45-degree field of view:
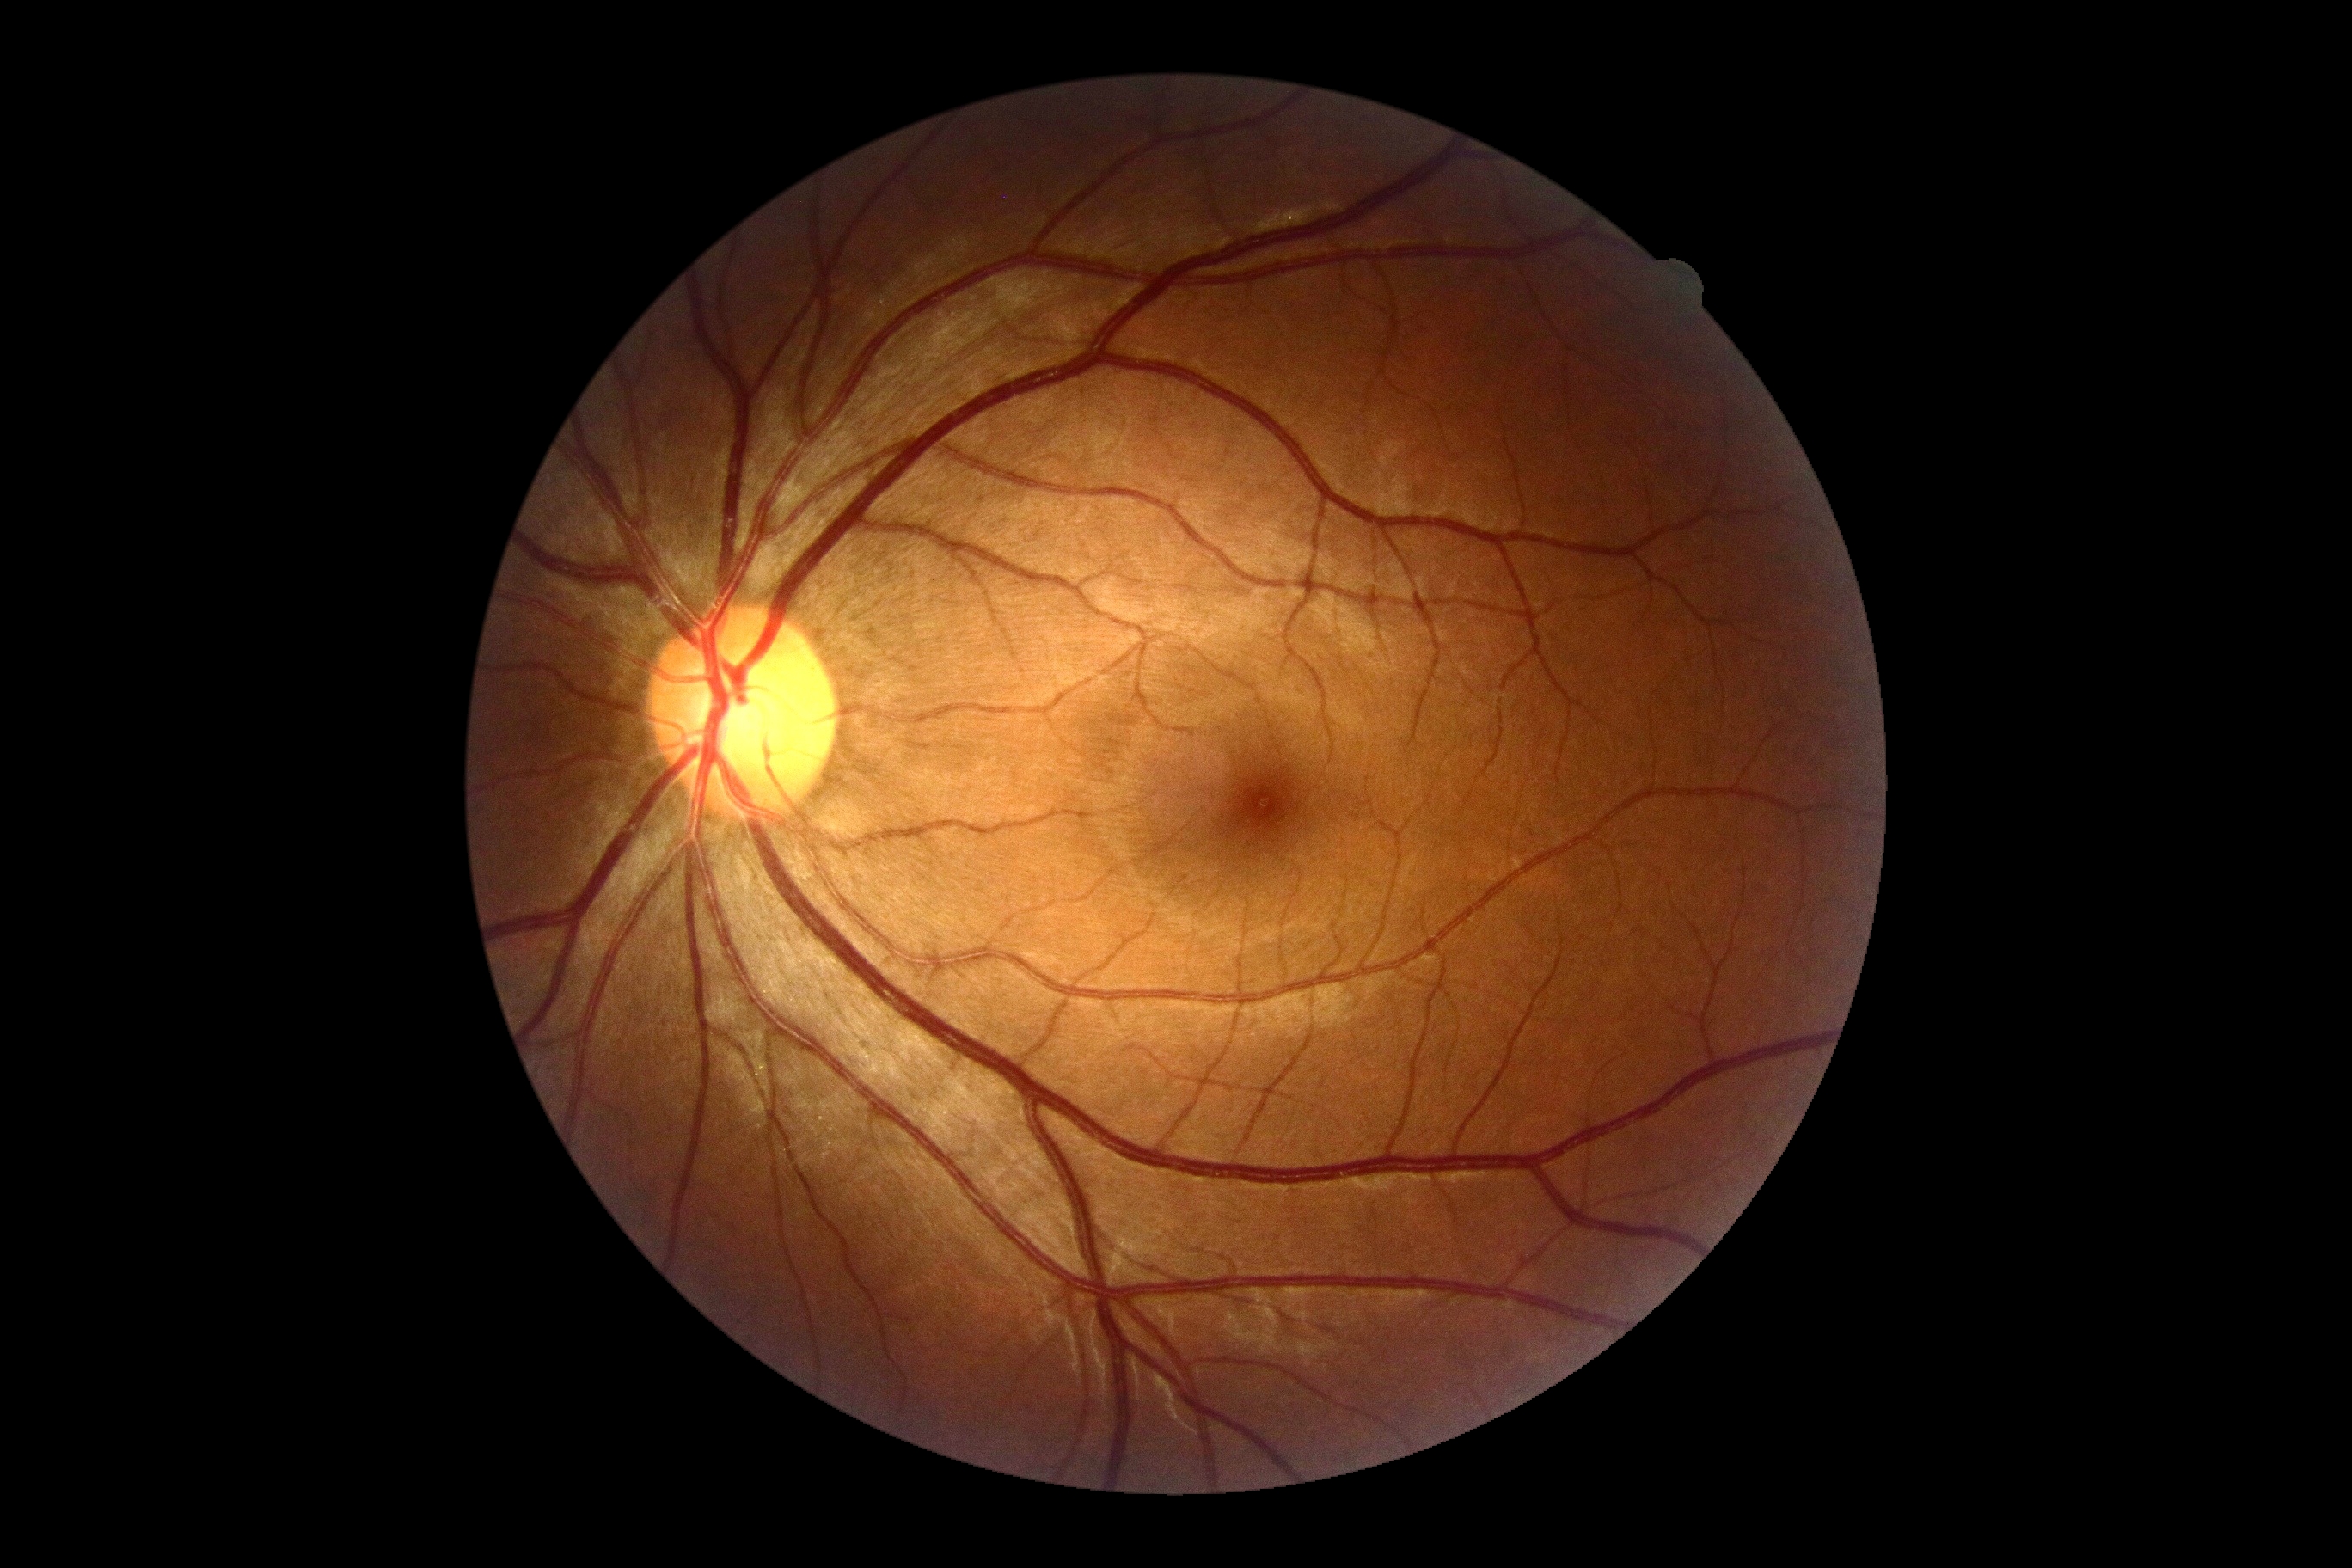 Annotations:
- retinopathy grade — 0